NIDEK AFC-230 fundus camera.
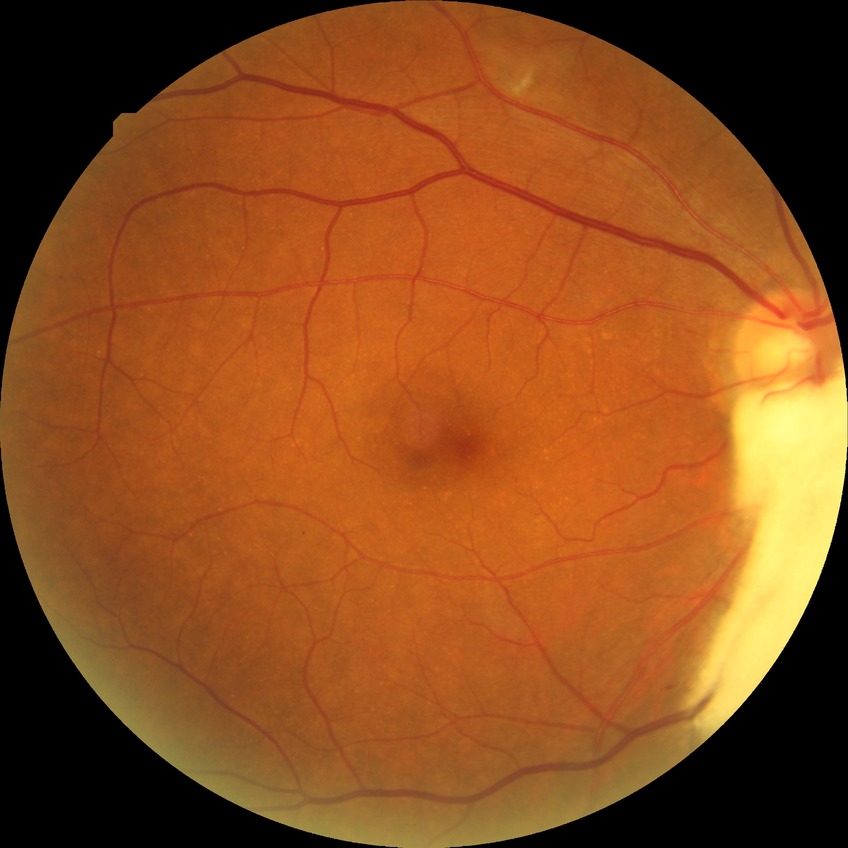

modified Davis grading = pre-proliferative diabetic retinopathy.